Pediatric wide-field fundus photograph — 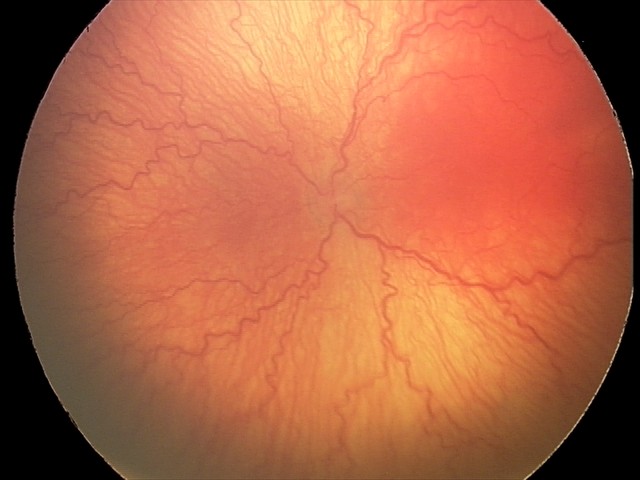

Plus disease was diagnosed.
Diagnosis from this screening exam: aggressive retinopathy of prematurity — rapidly progressive severe ROP with prominent plus disease, often without classic stage progression.